Camera: Topcon TRC-NW8 — 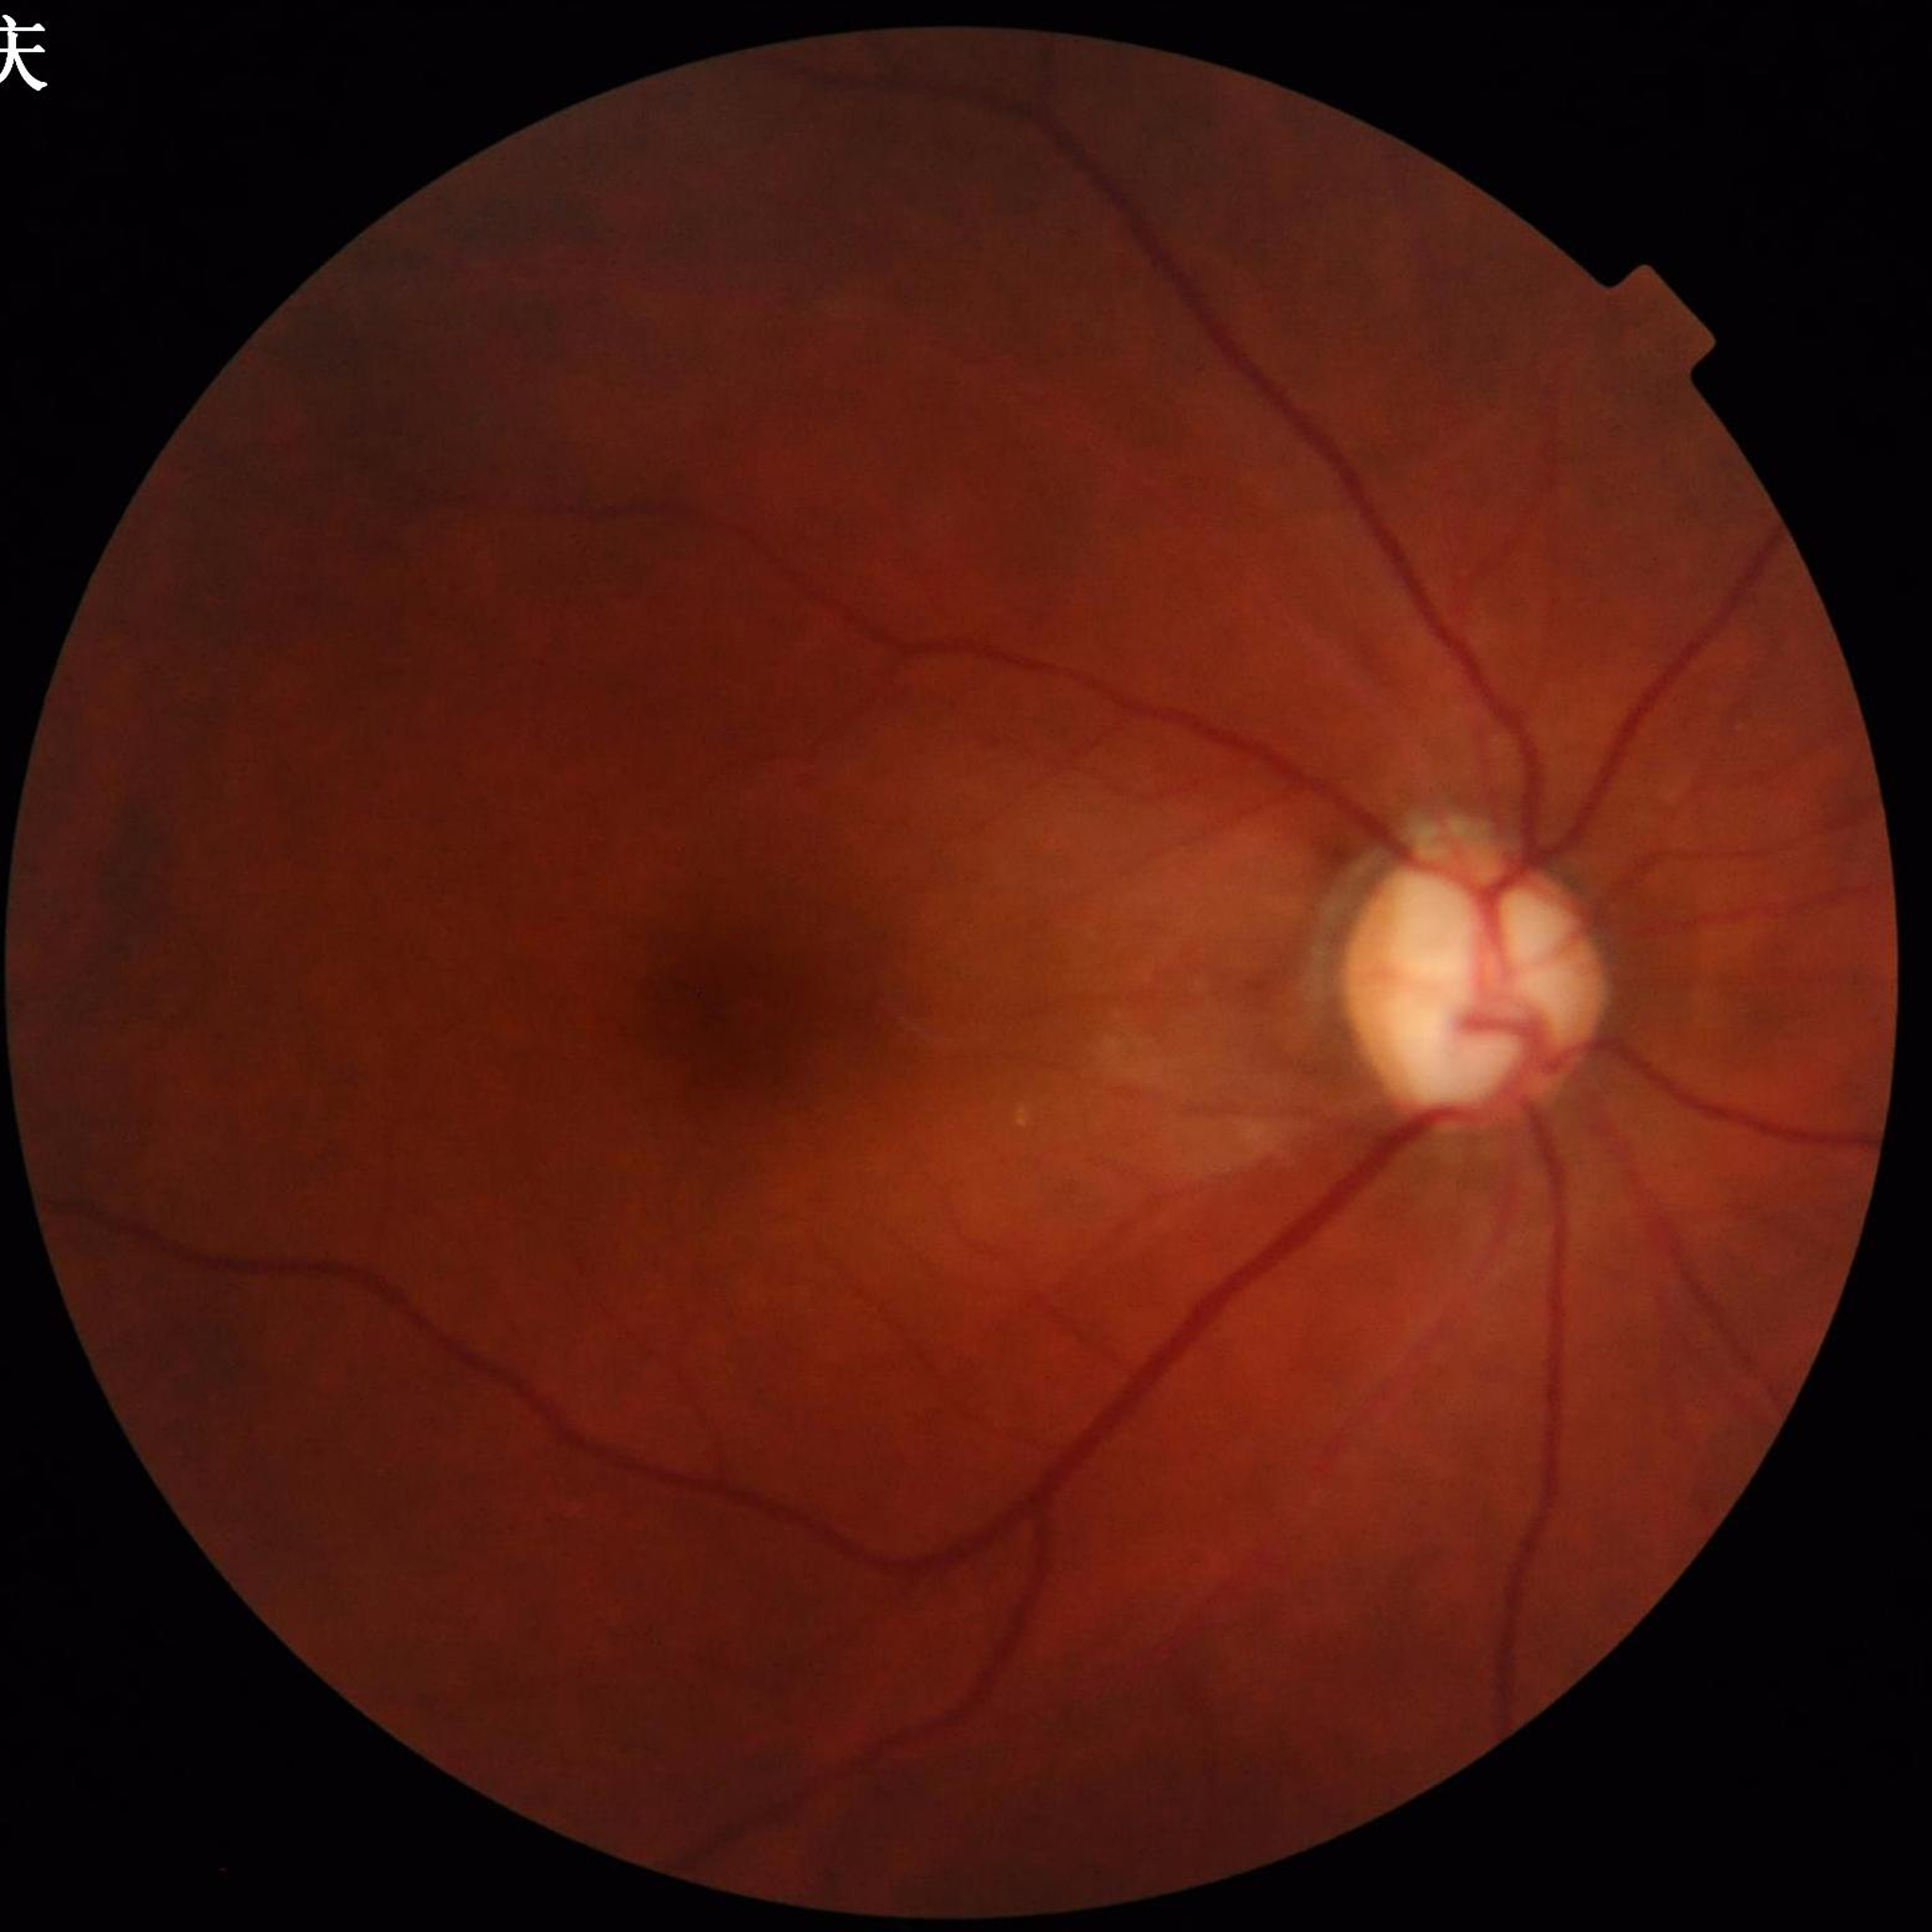
Disease = glaucoma